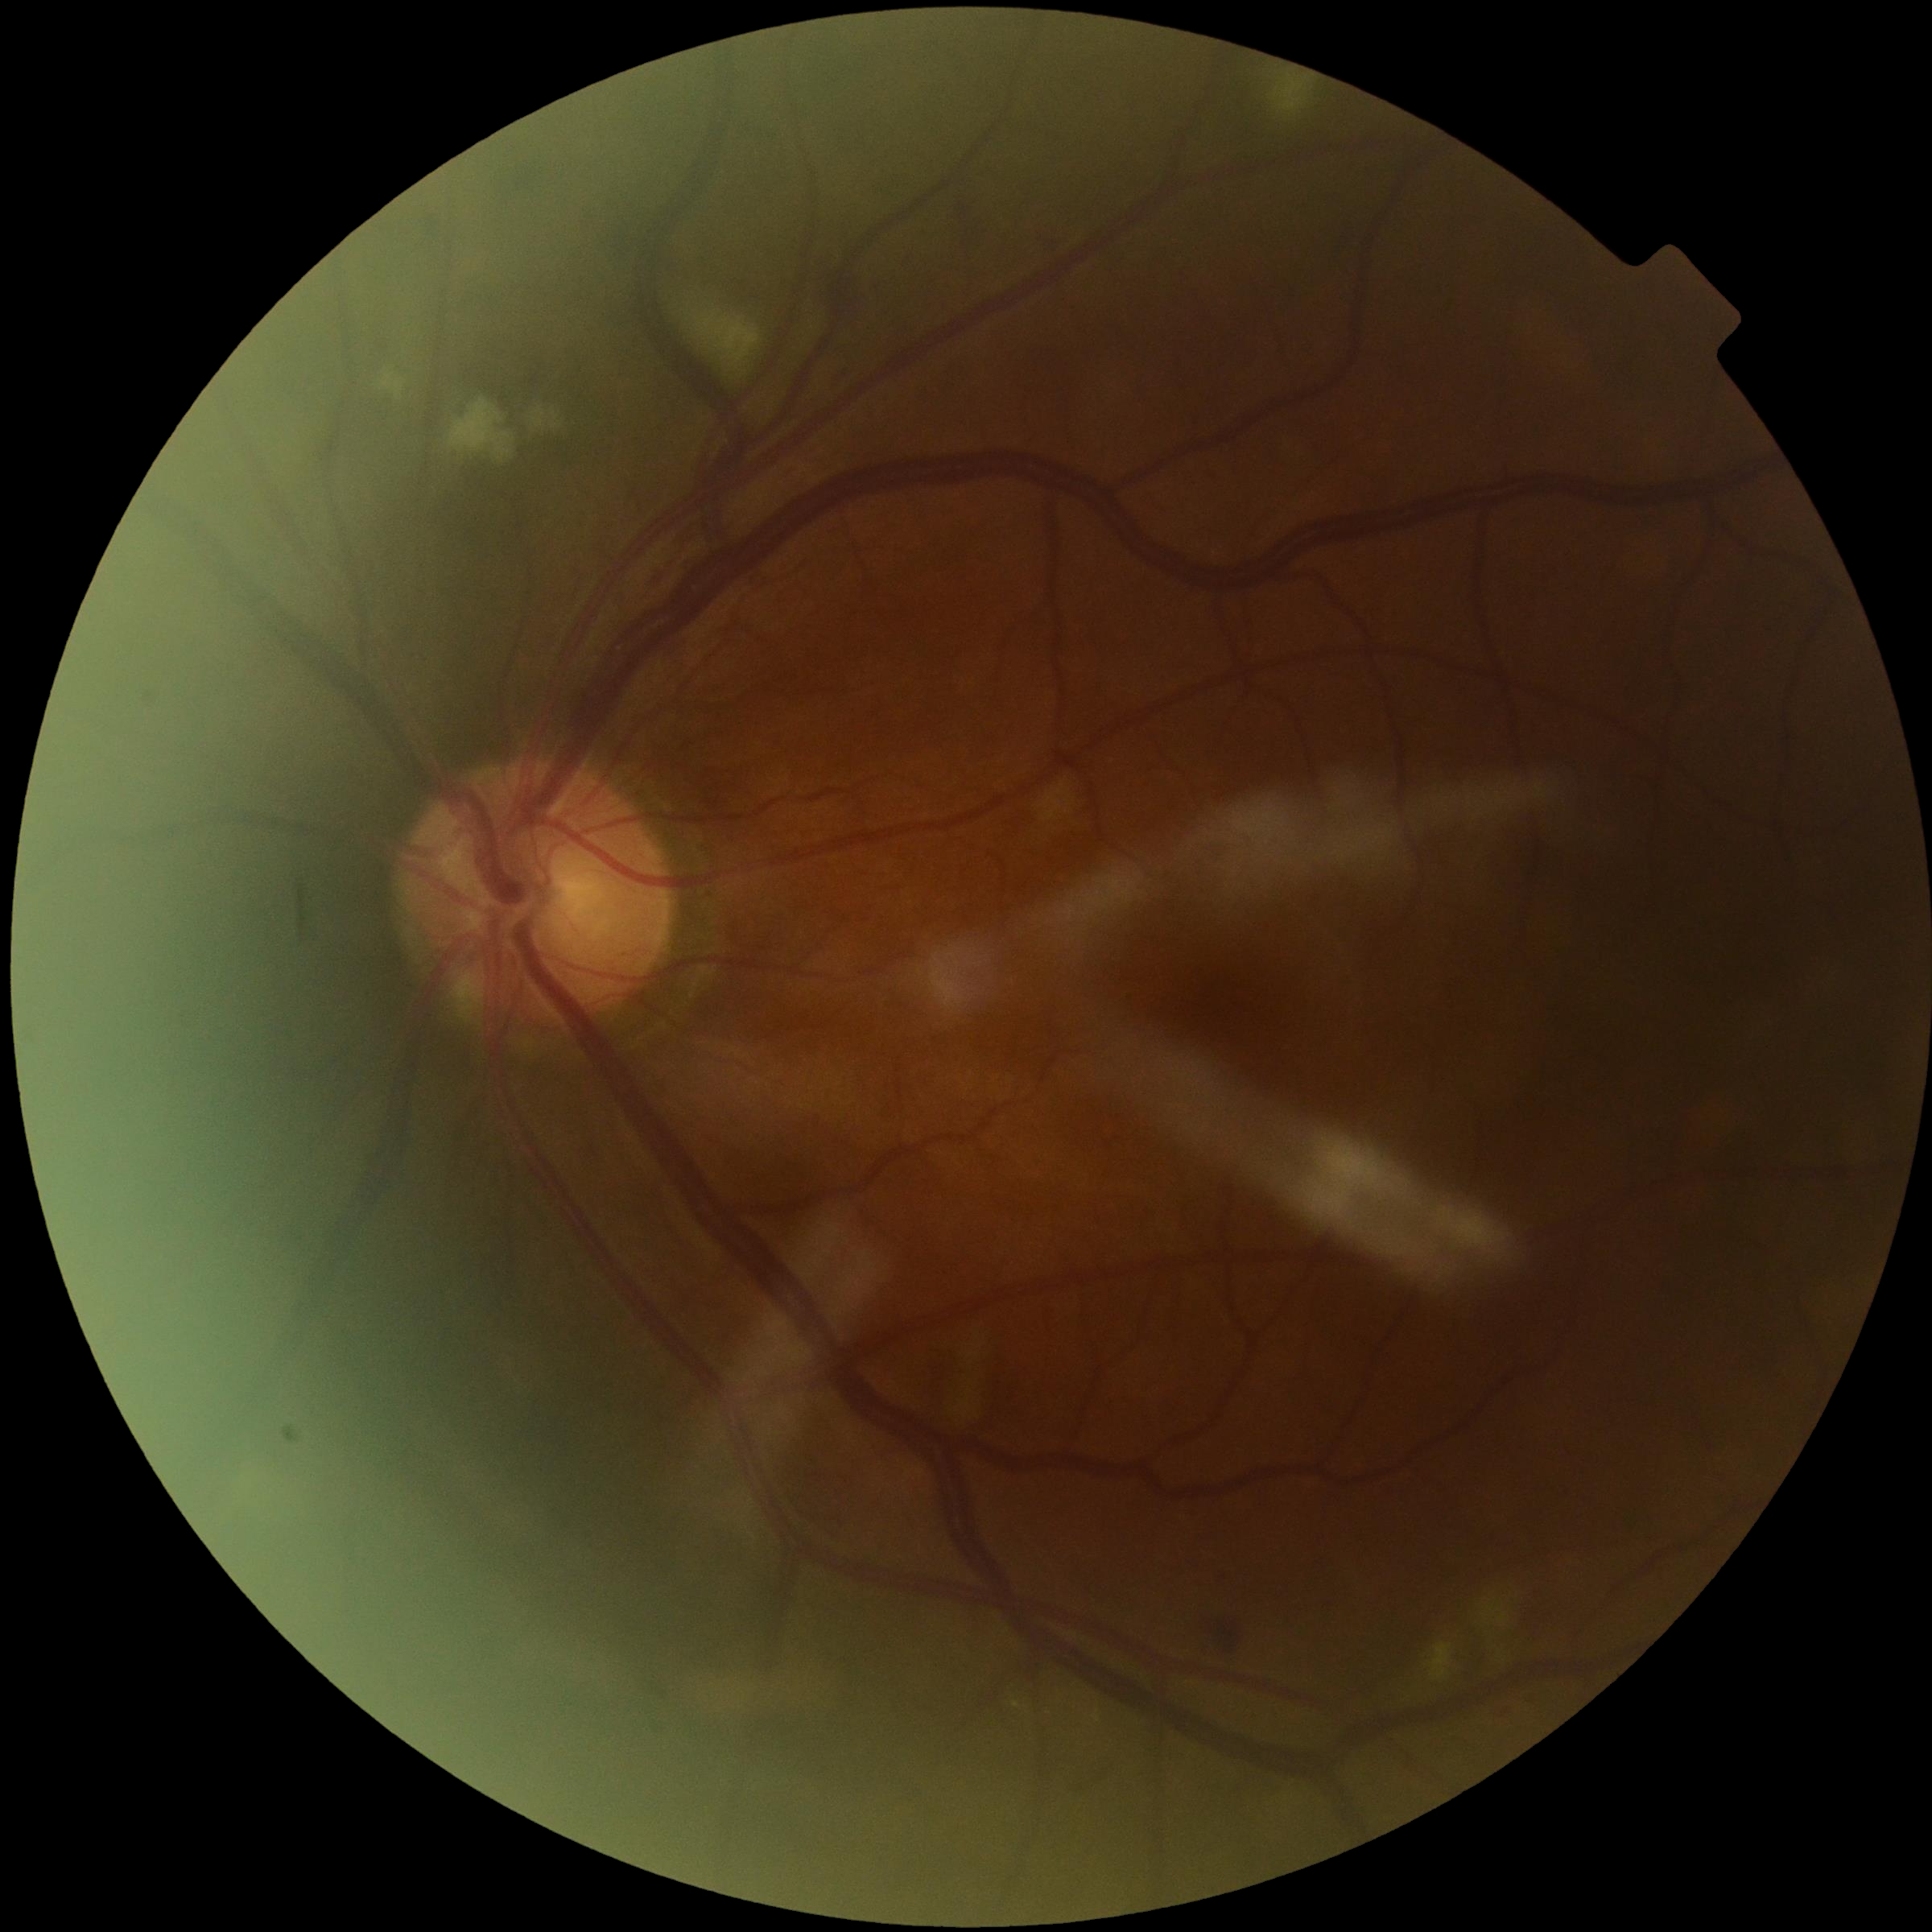
Diabetic retinopathy grade: moderate non-proliferative diabetic retinopathy (2) — more than just microaneurysms but less than severe NPDR.
The retinopathy is classified as non-proliferative diabetic retinopathy.